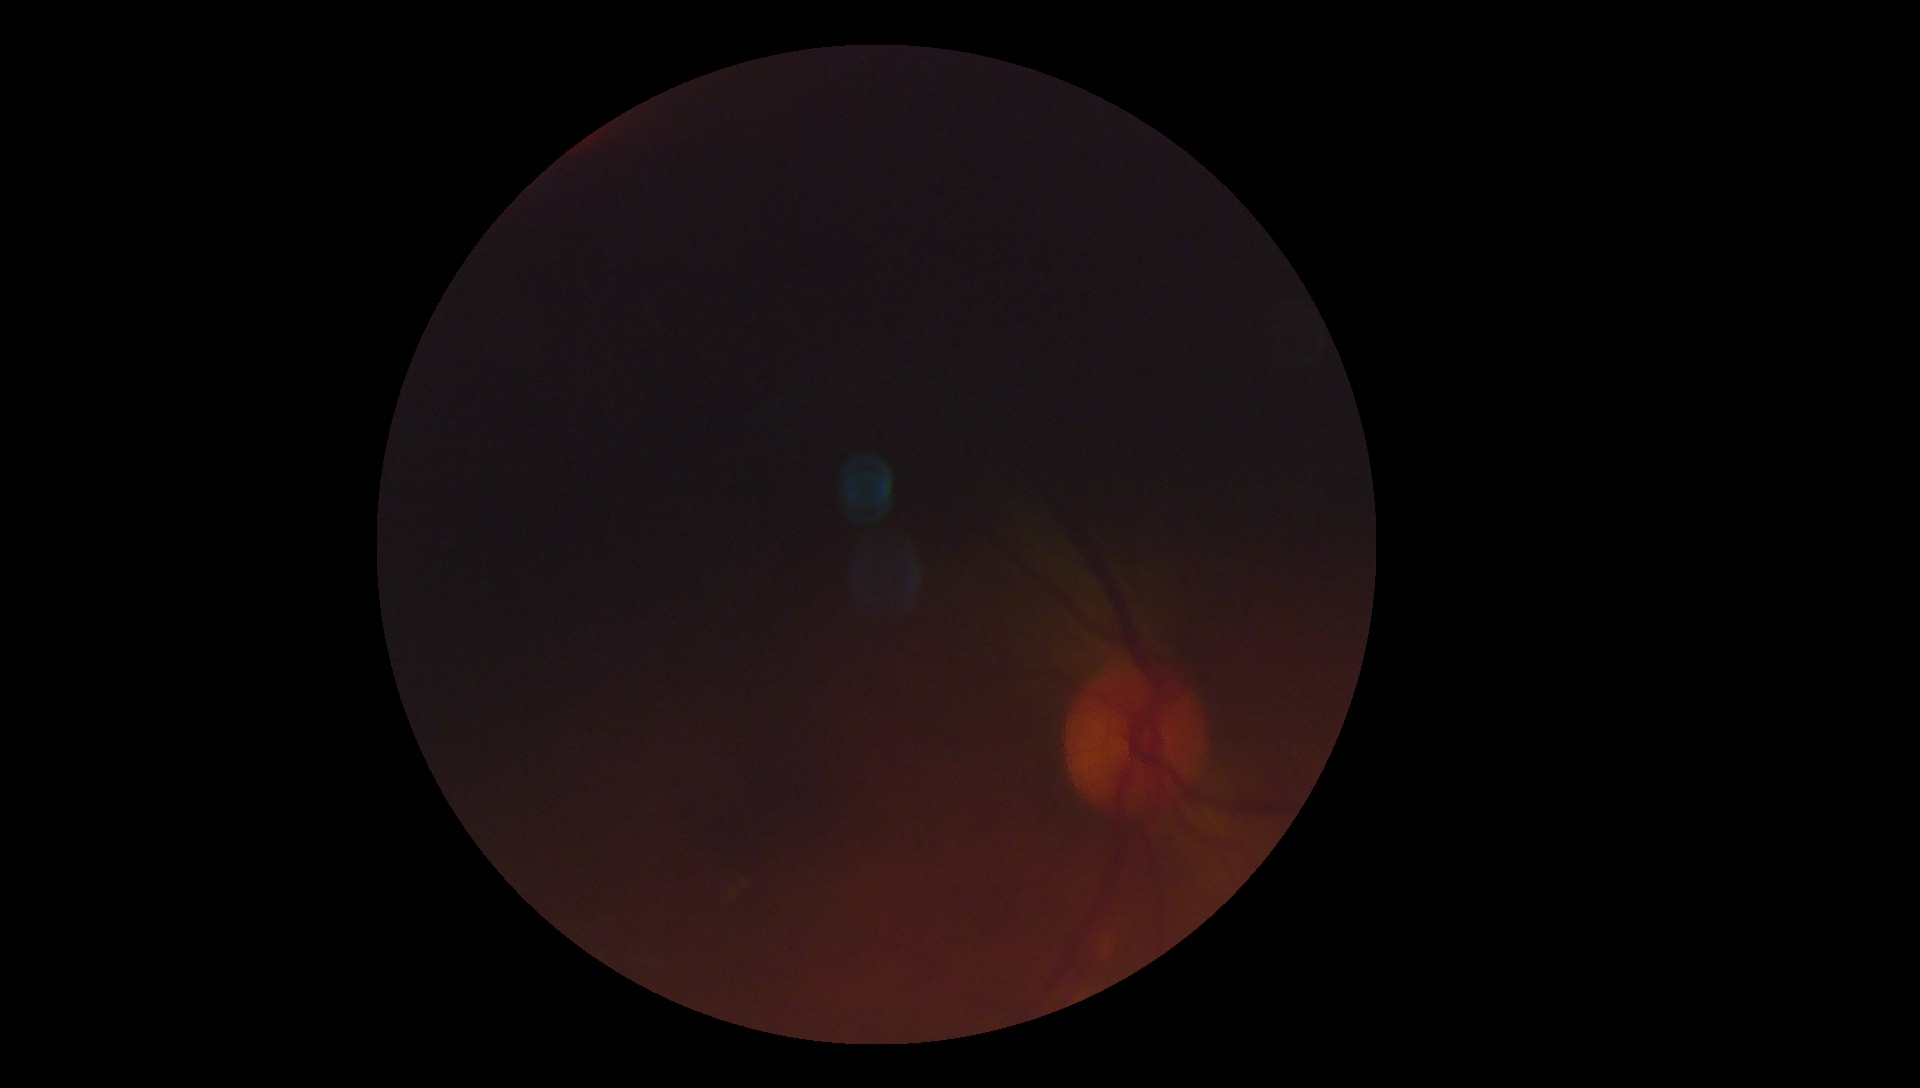
Retinopathy is ungradable due to poor image quality.